Pediatric wide-field fundus photograph
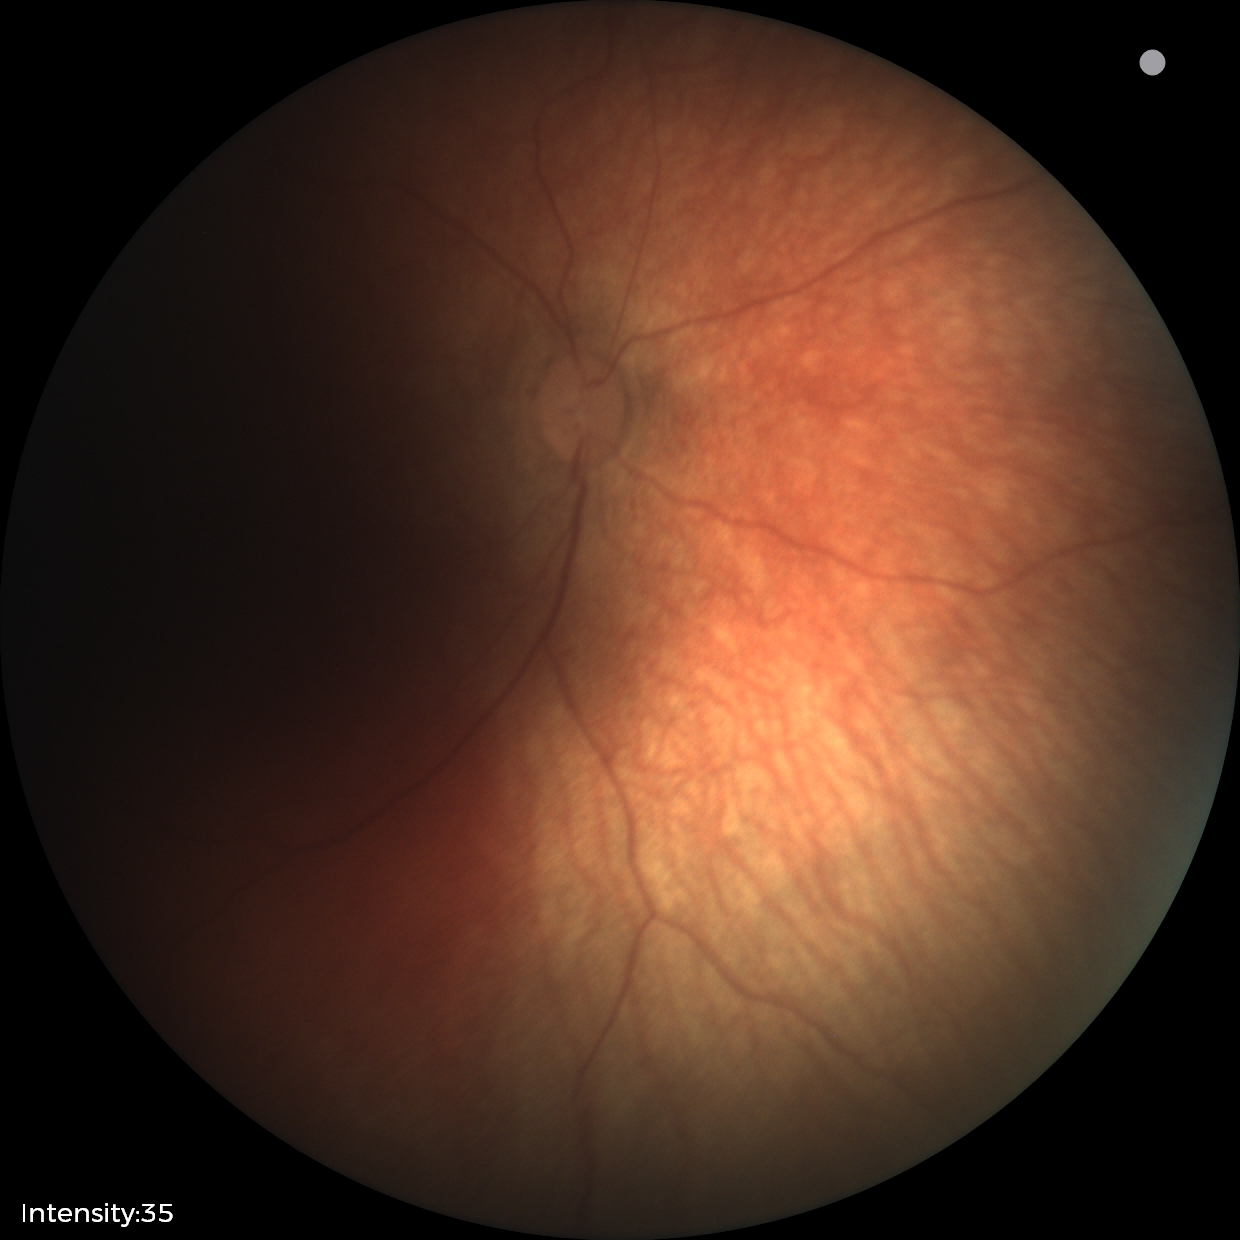

Assessment: physiological retinal finding.